45° field of view · color fundus image · 1444 by 1444 pixels:
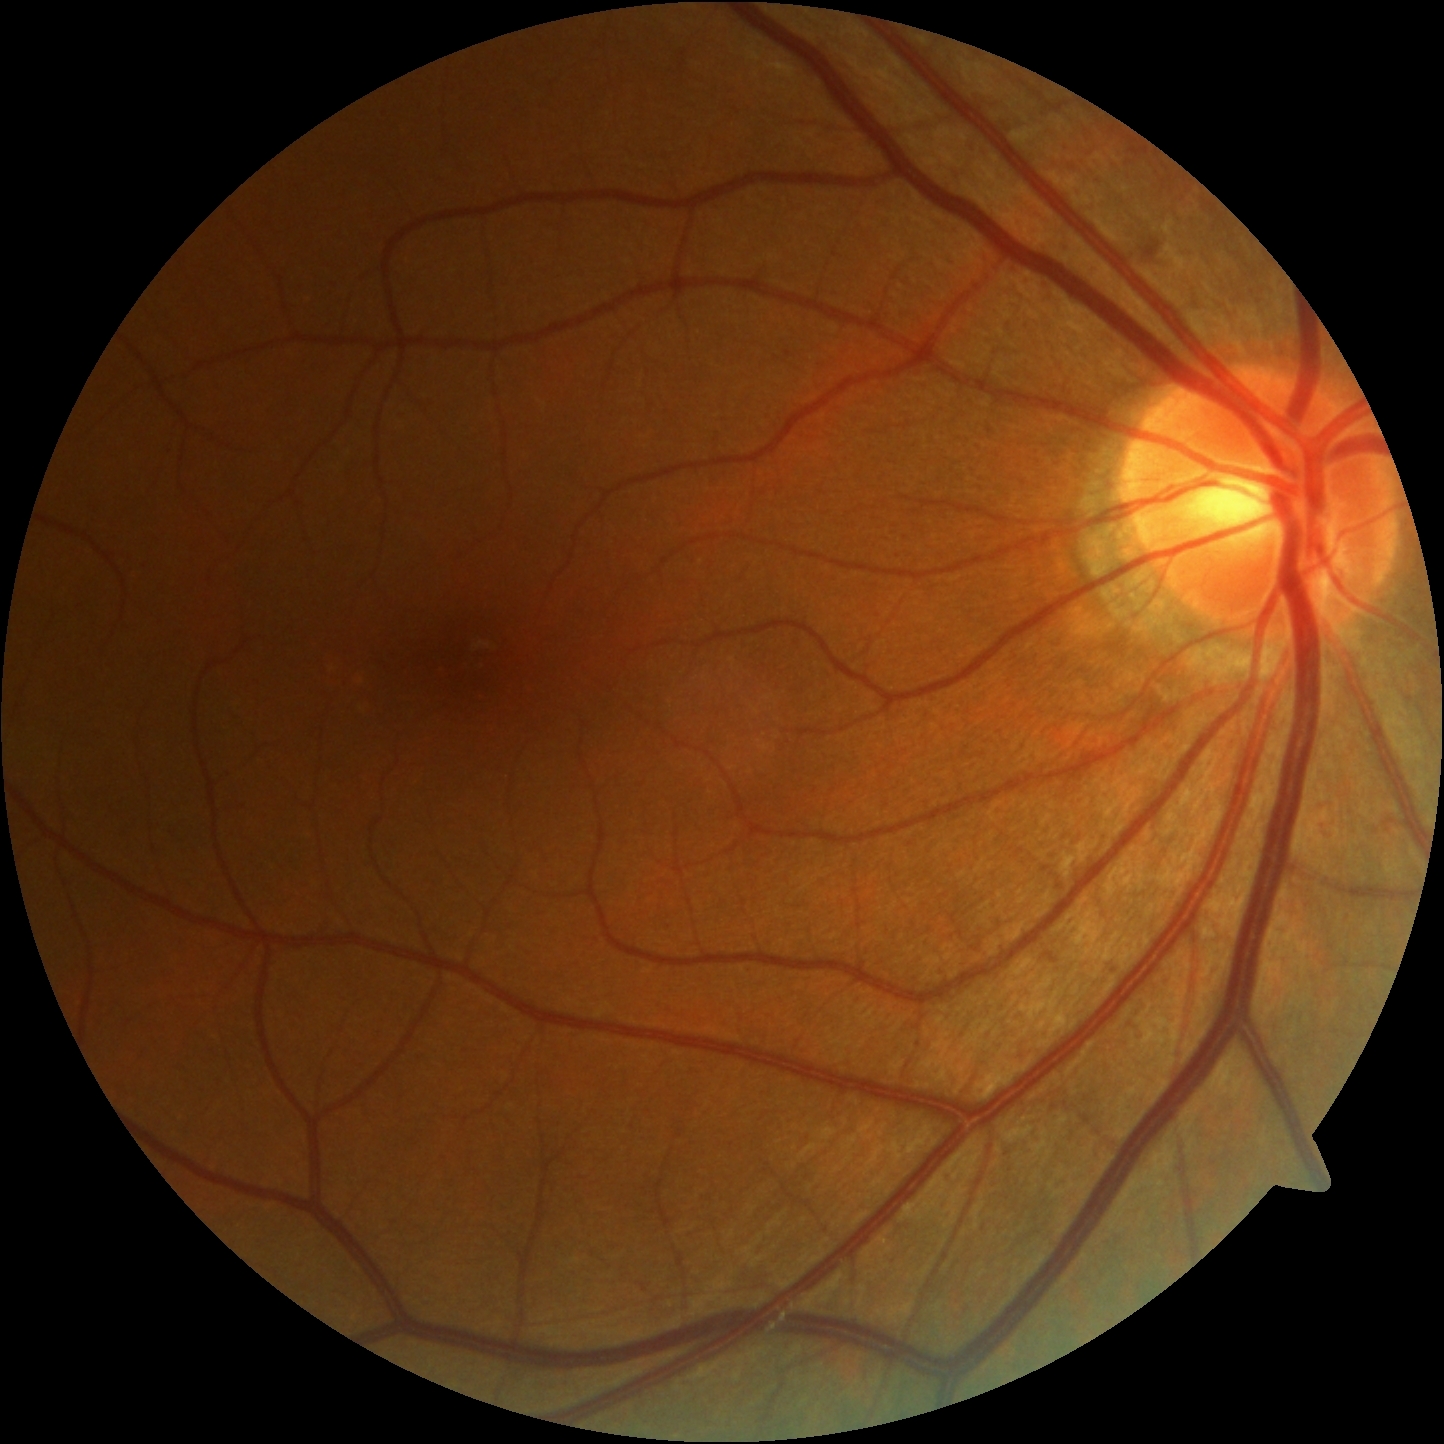

Retinopathy grade: 2/4. Disease class: non-proliferative diabetic retinopathy.